Wide-field fundus image from infant ROP screening; Clarity RetCam 3, 130° FOV.
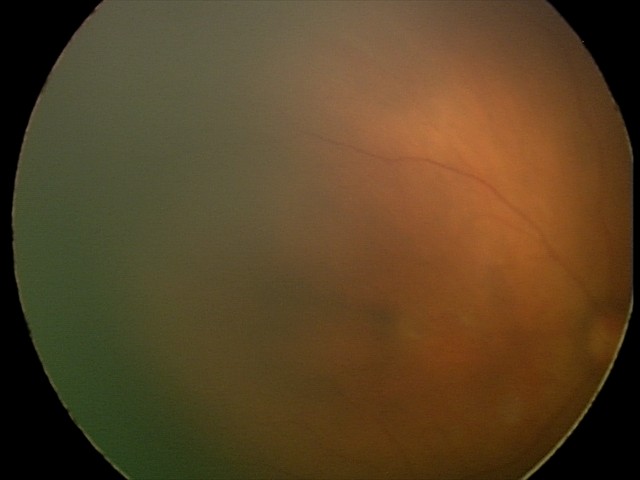 Impression: normal fundus examination.